Disc-centered field; refraction: +4 -1.75 x 95; pachymetry 543 µm; color fundus image: 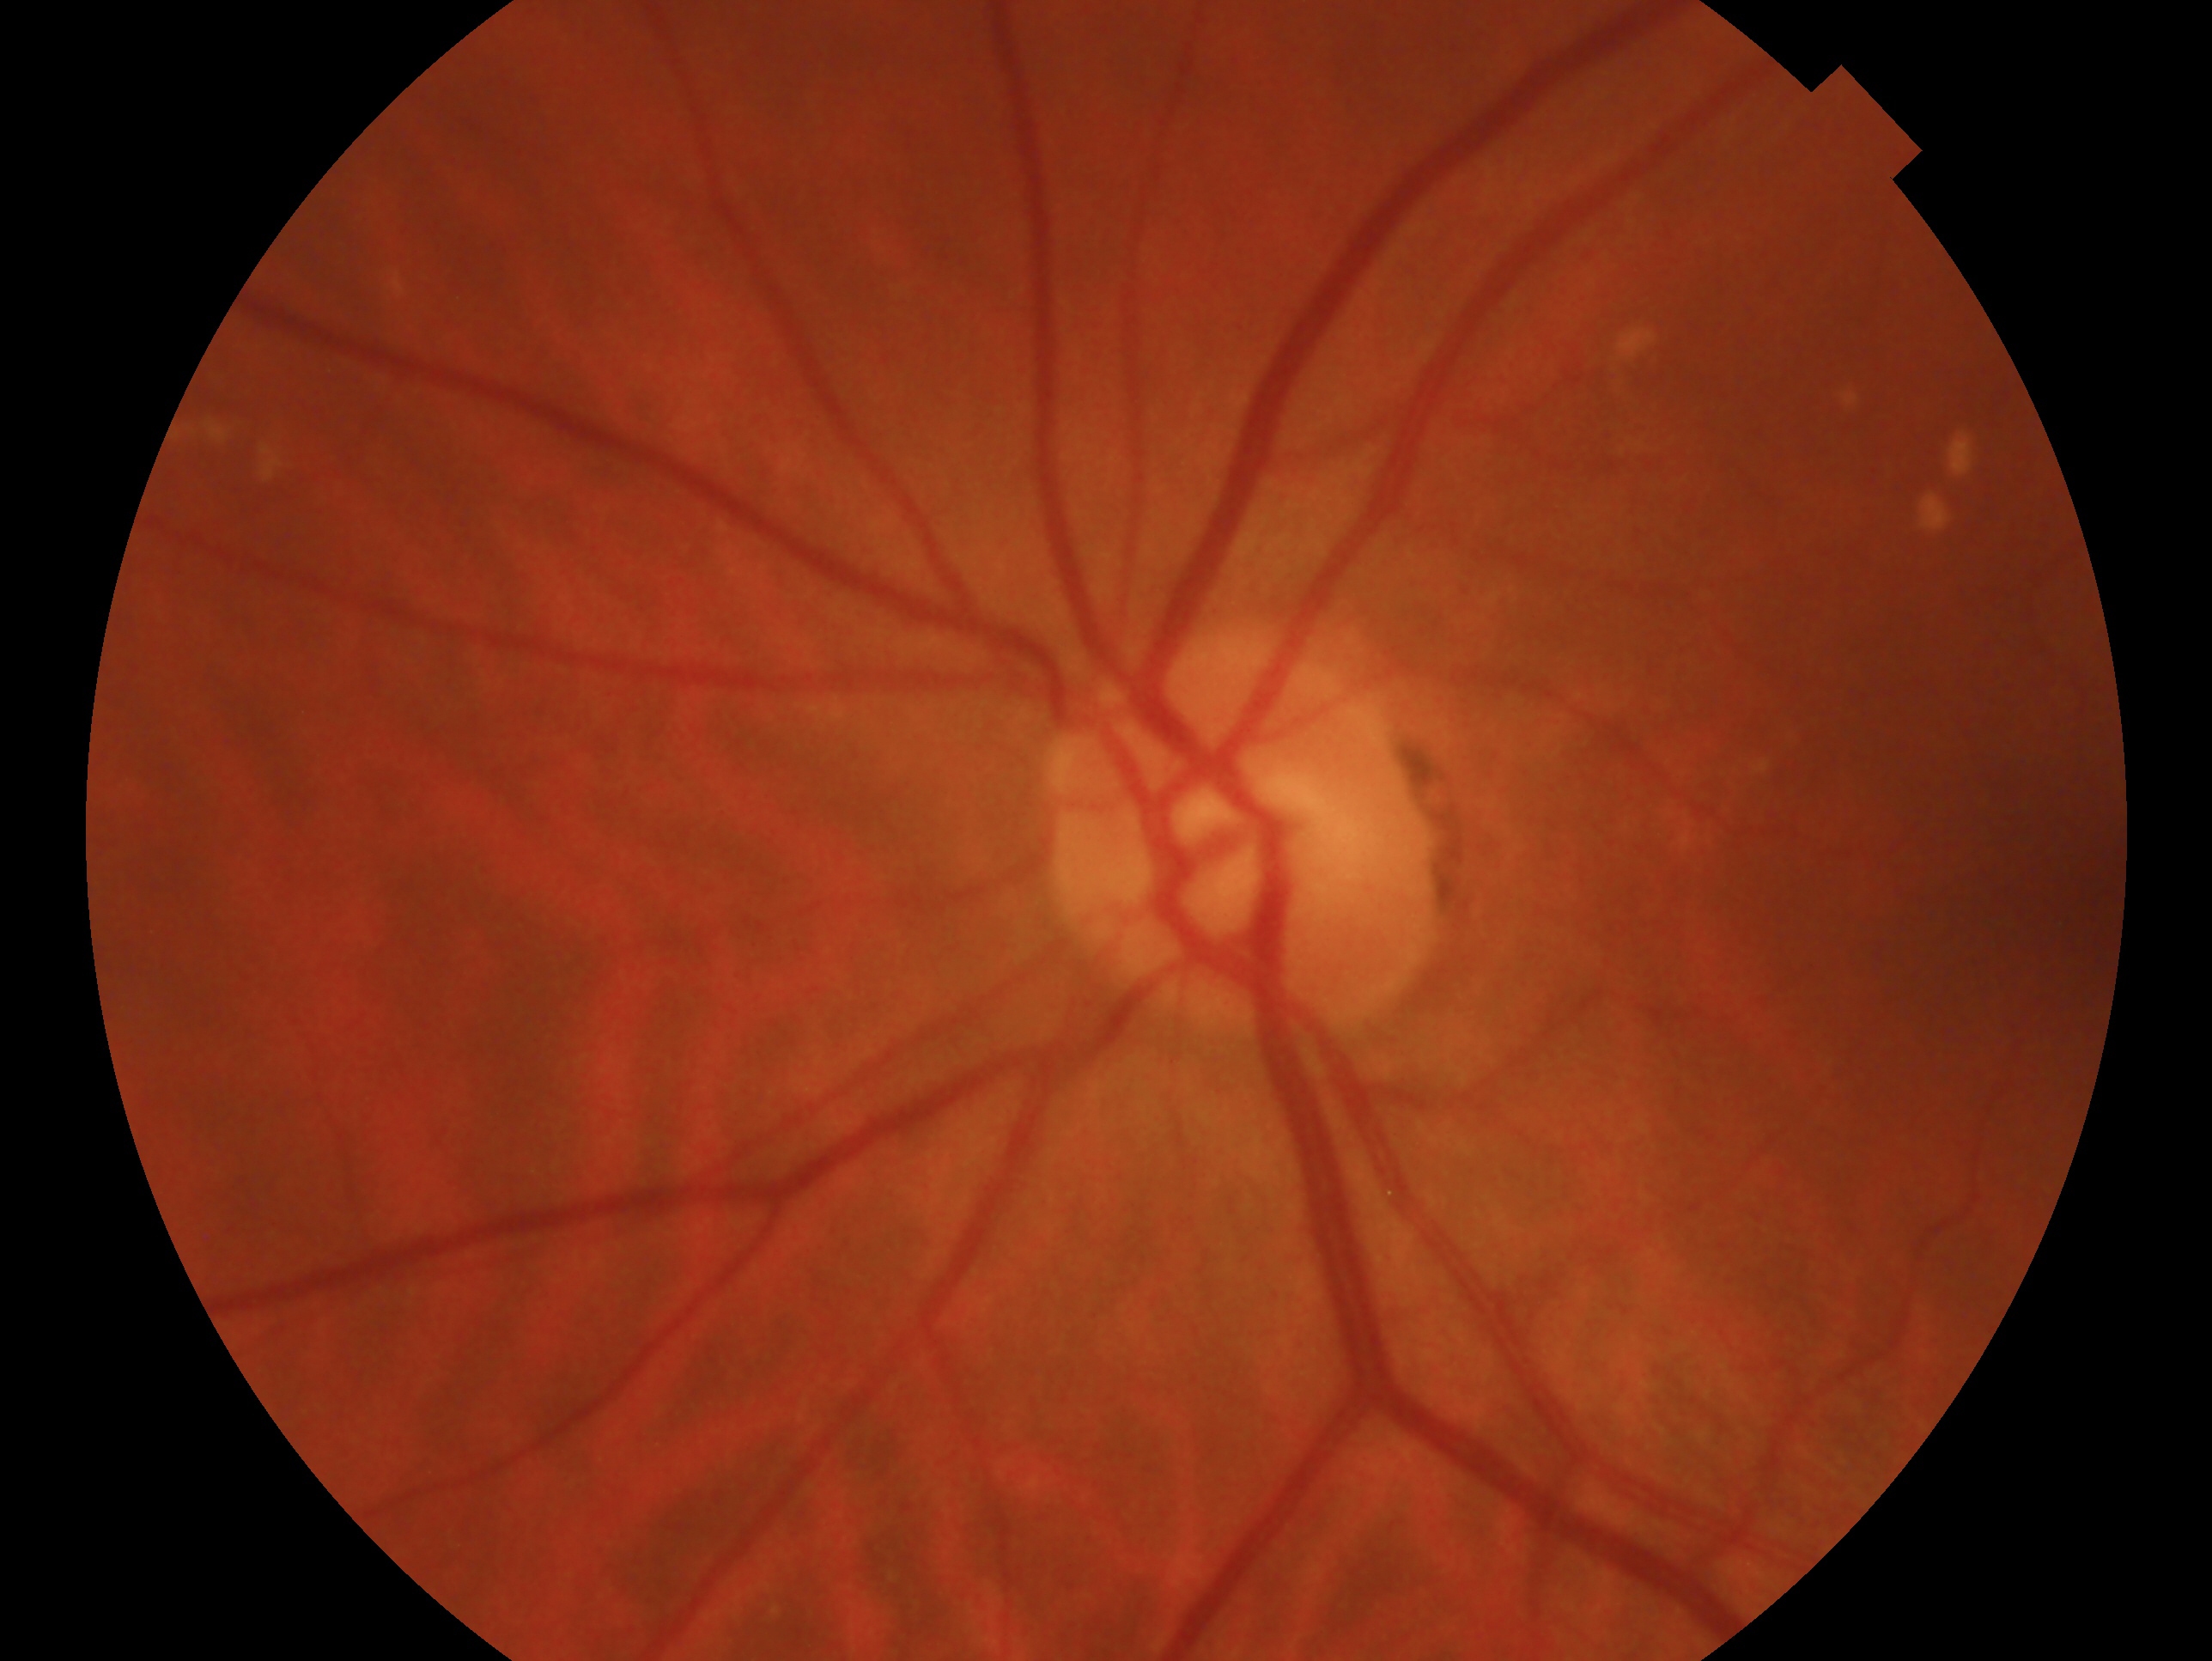

{
  "glaucoma_dx": "negative for glaucoma",
  "eye": "left"
}